848x848px, no pharmacologic dilation, NIDEK AFC-230, 45 degree fundus photograph, fundus photo
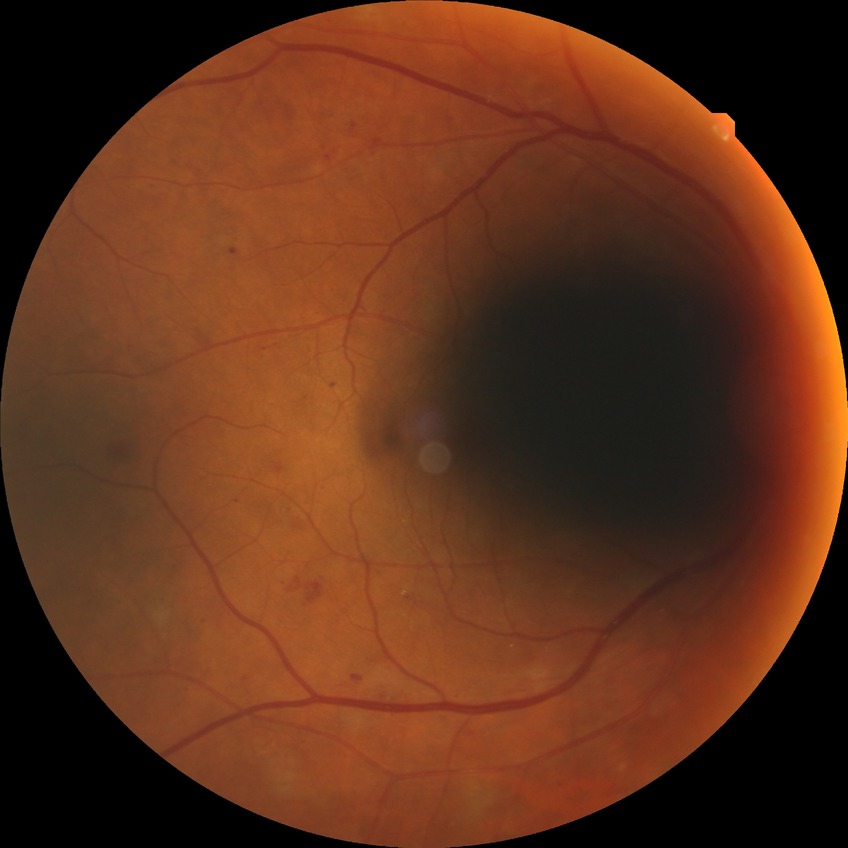

Diabetic retinopathy (DR) is pre-proliferative diabetic retinopathy (PPDR).